DR severity per modified Davis staging; nonmydriatic; NIDEK AFC-230; 848 by 848 pixels: 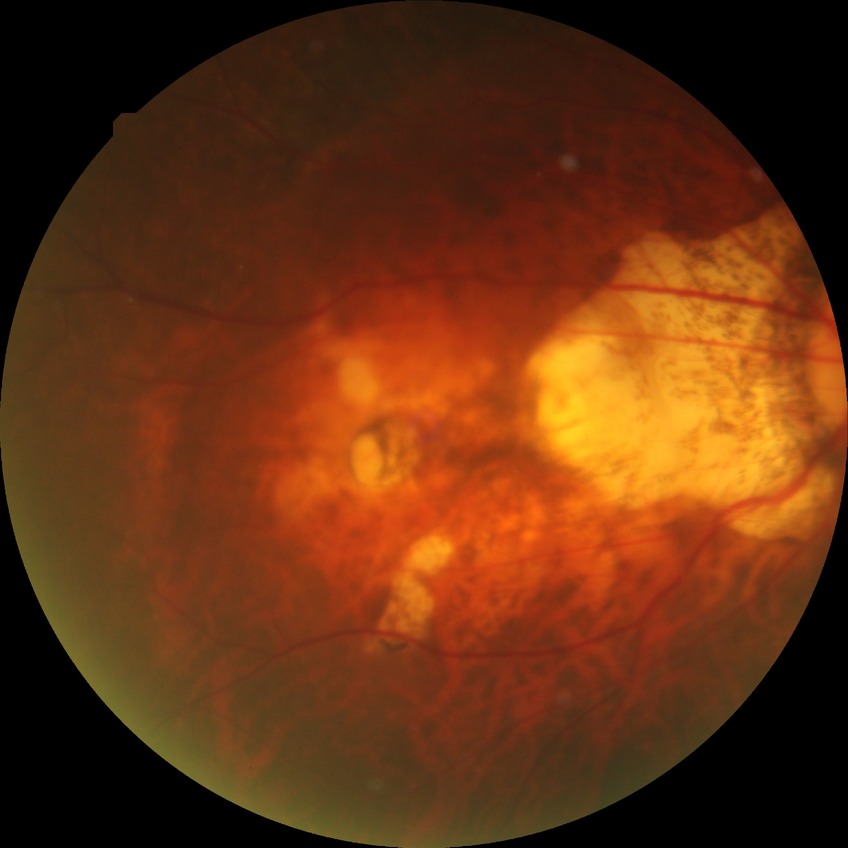
Findings:
– modified Davis classification — no diabetic retinopathy